Woman patient; IOP: 20 mmHg
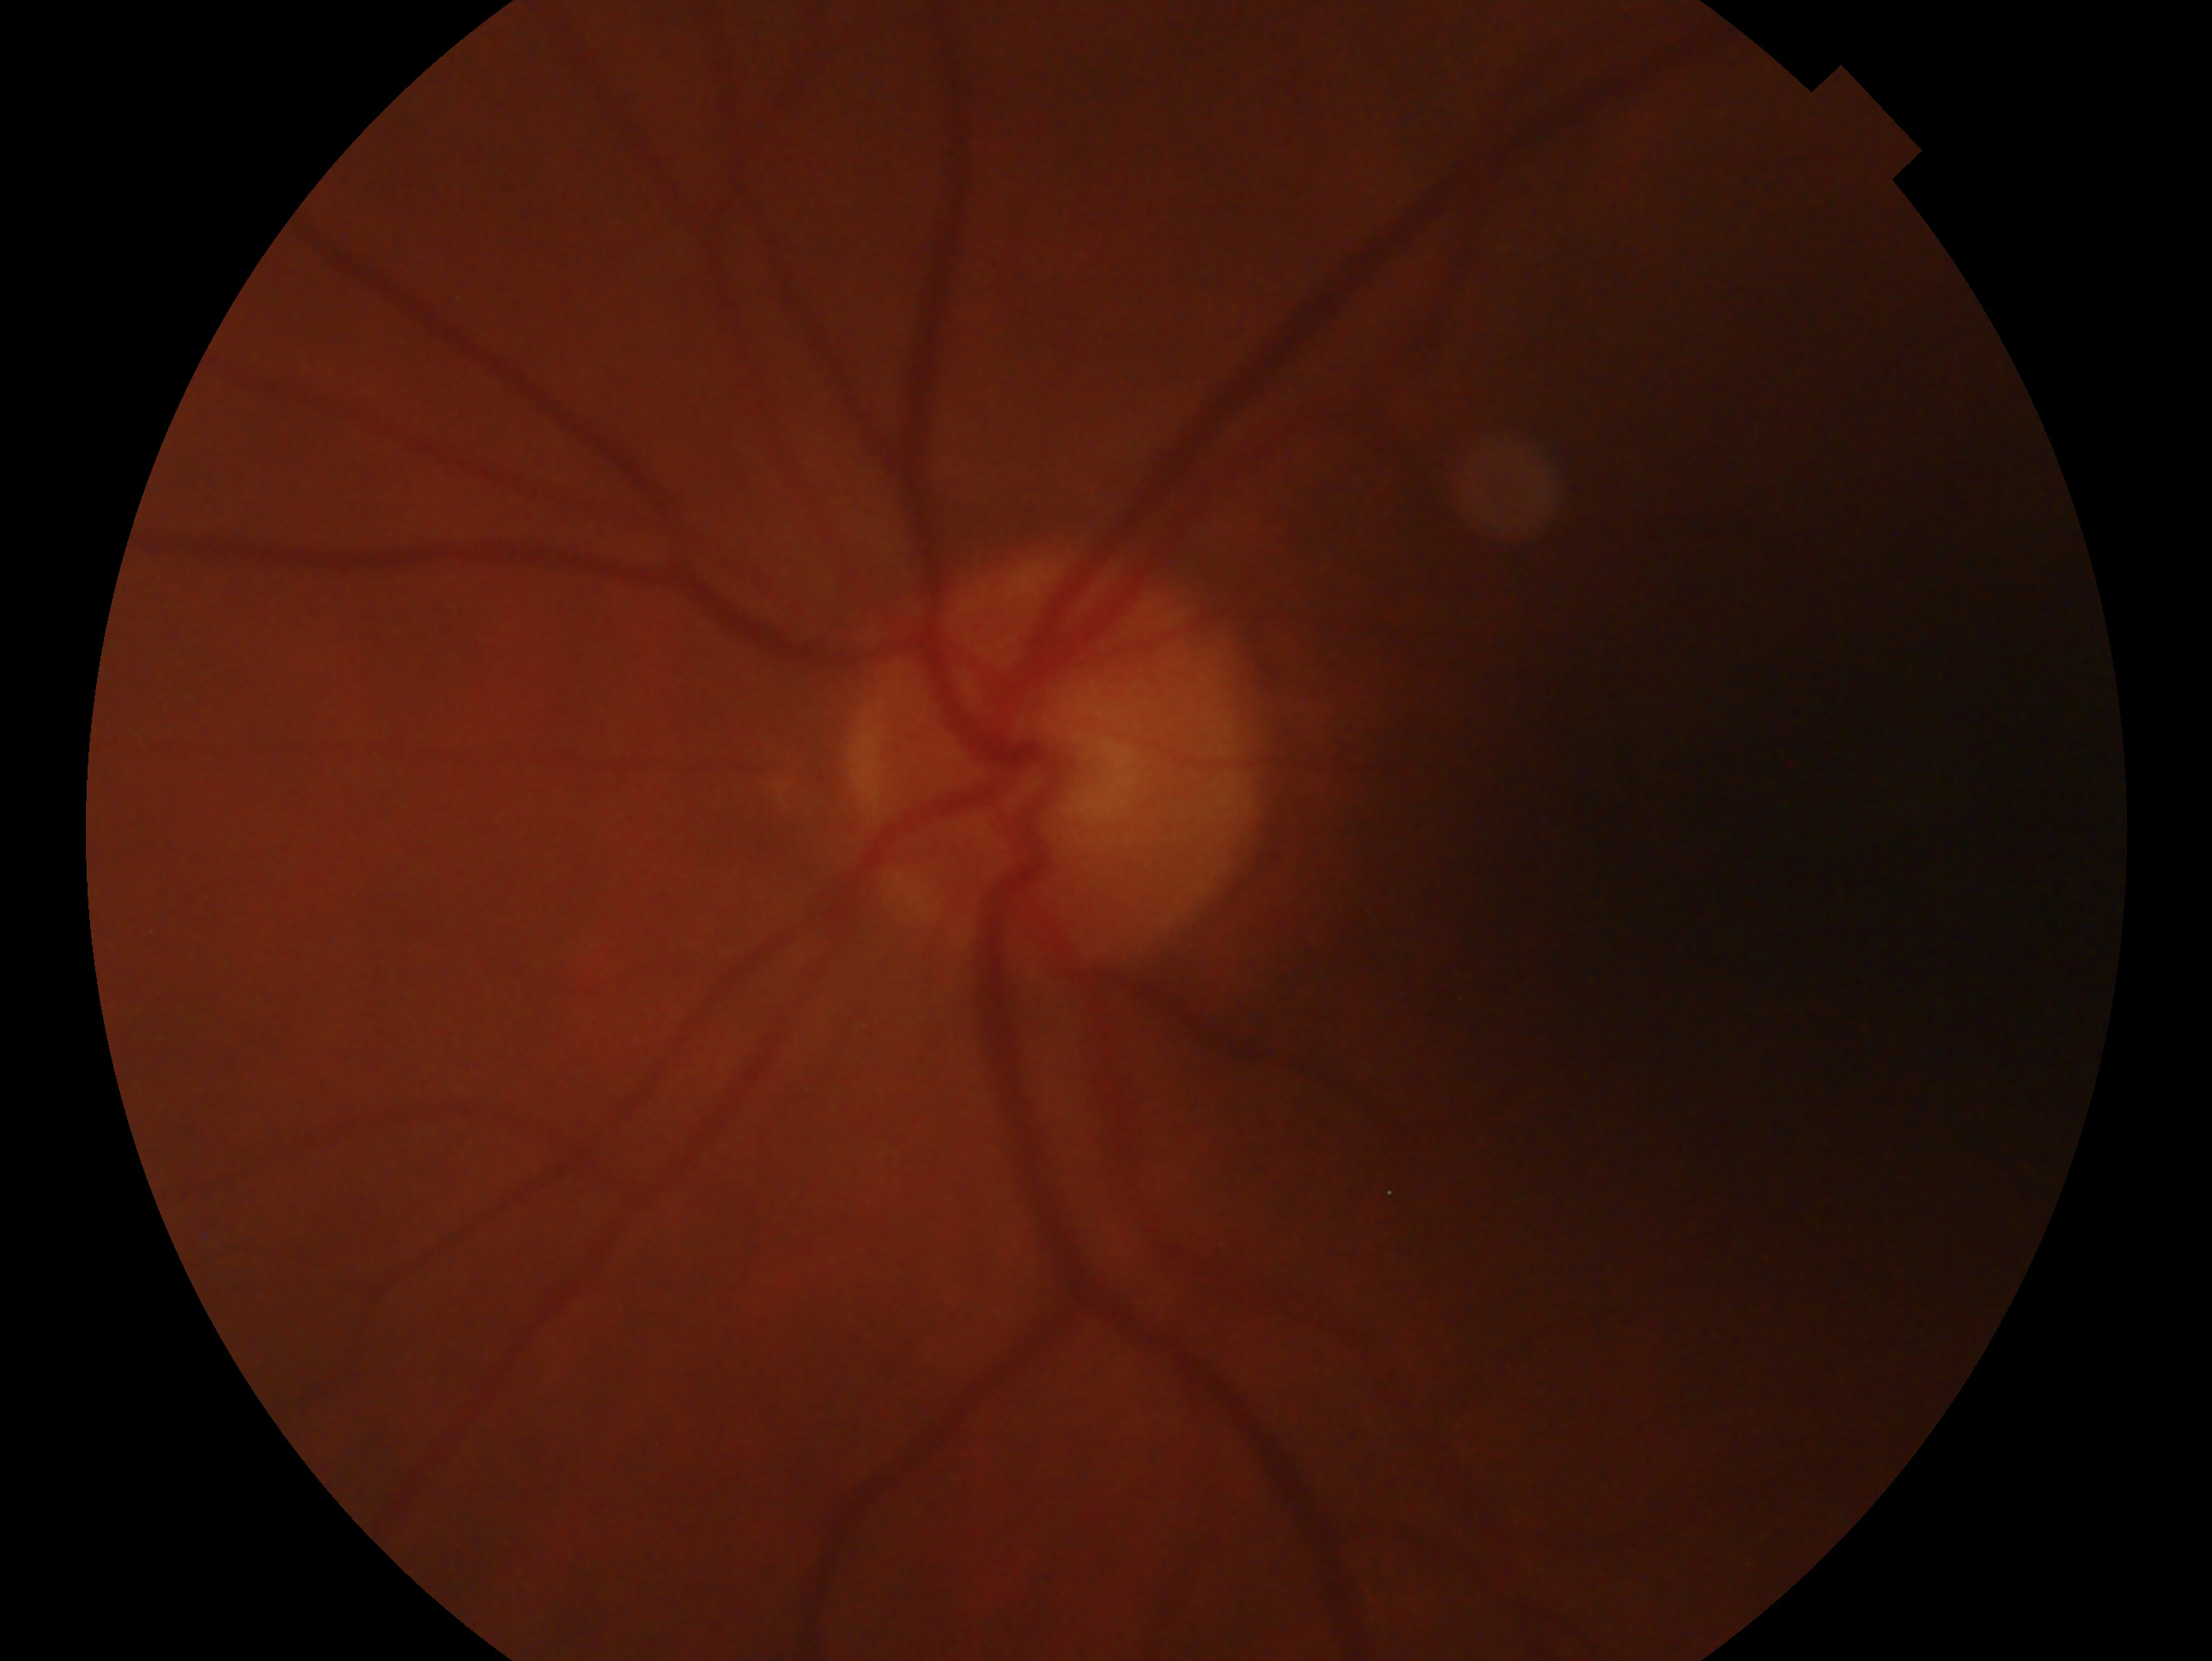 laterality: left eye
glaucoma assessment: cannot be excluded